Tabletop color fundus camera image: 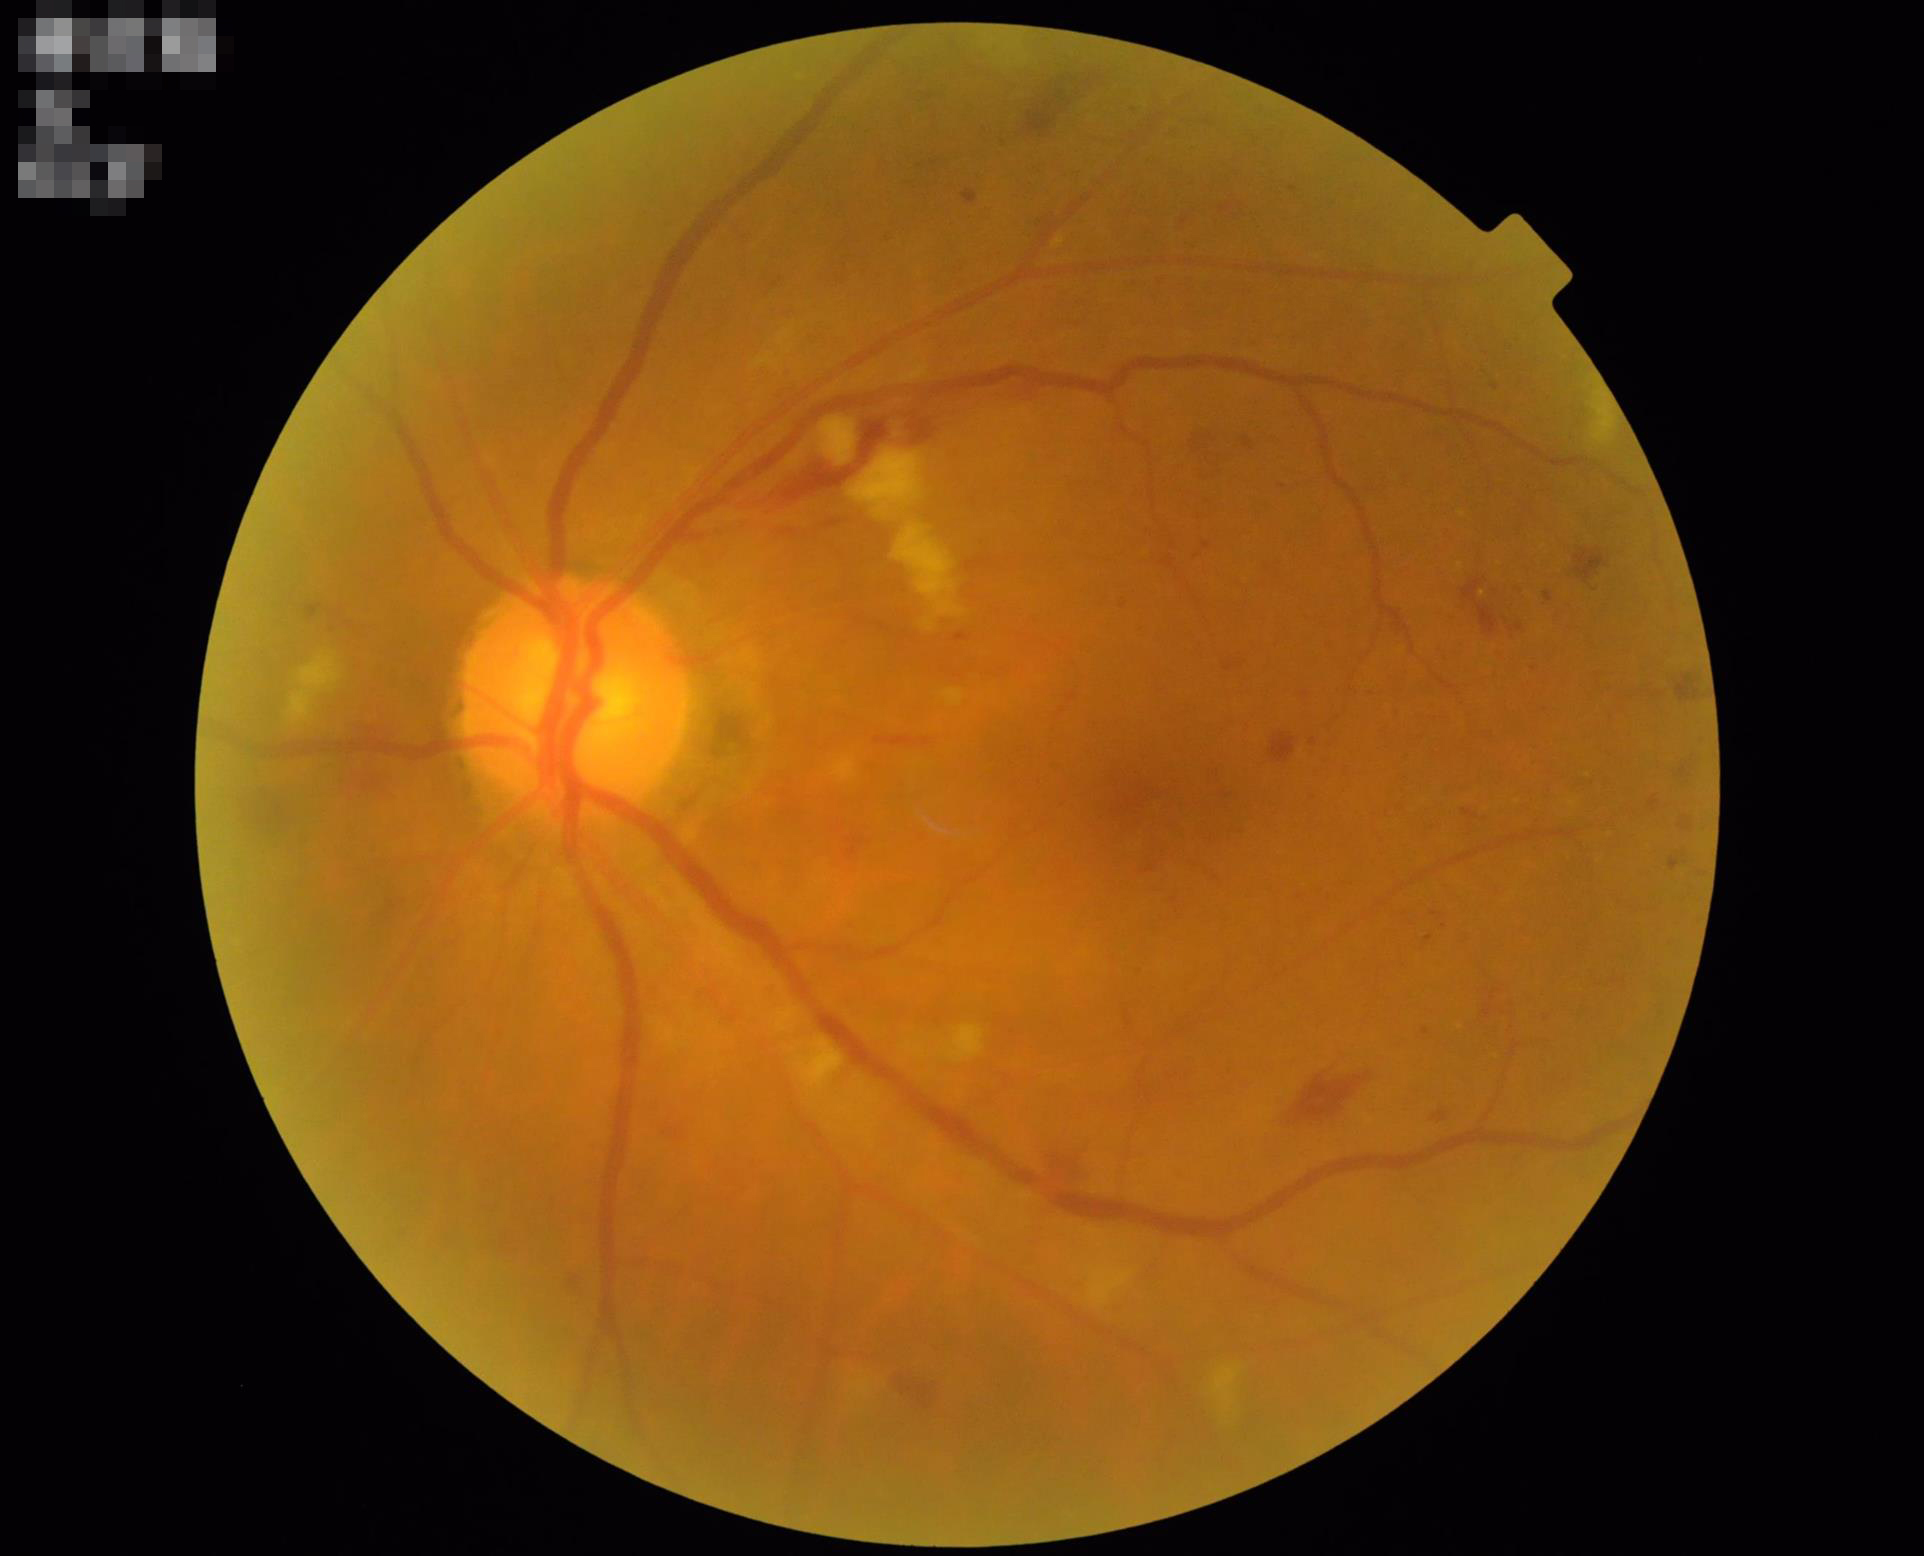

Illumination is even. Overall quality is good and the image is gradable. The image is clear. Contrast is good.